848 by 848 pixels · NIDEK AFC-230 · no pharmacologic dilation · diabetic retinopathy graded by the modified Davis classification · 45 degree fundus photograph:
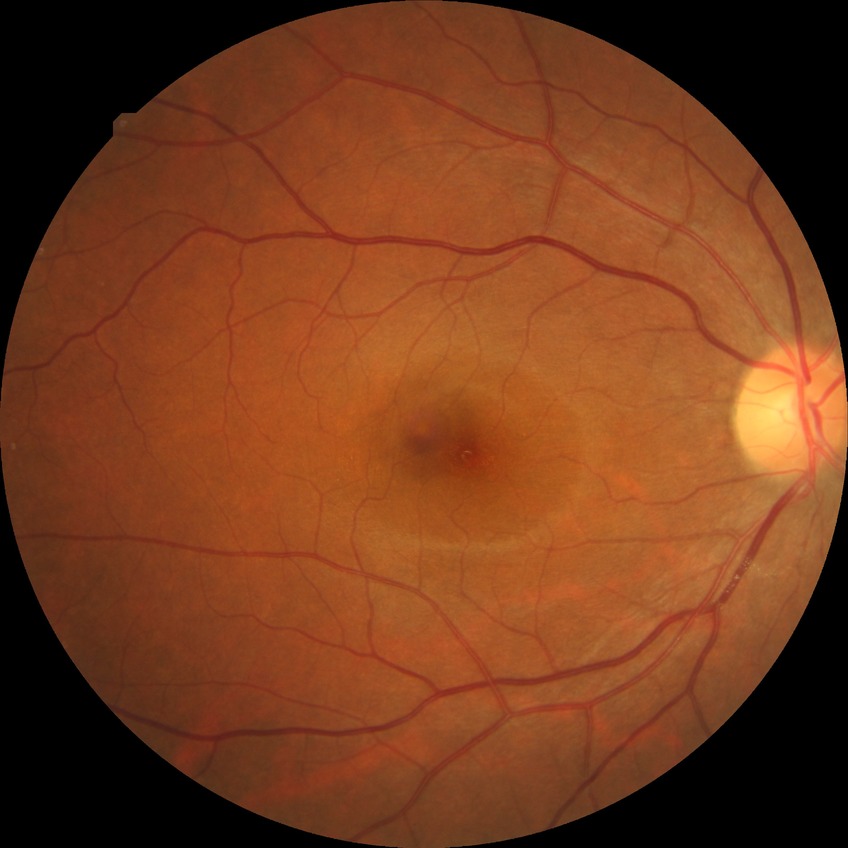
Diabetic retinopathy (DR): NDR (no diabetic retinopathy).